Infant wide-field retinal image:
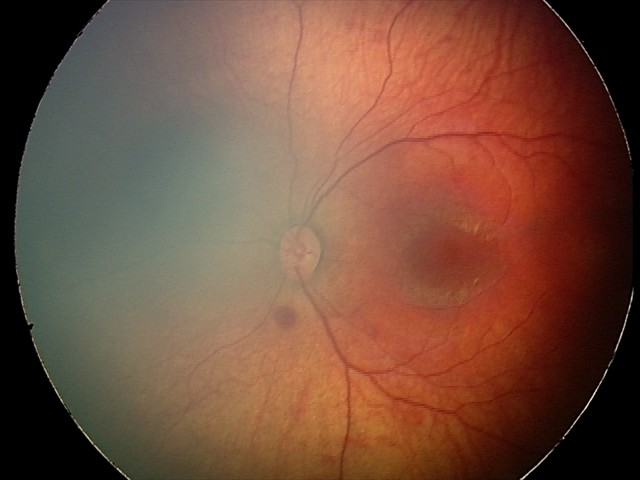

Screening examination consistent with retinal hemorrhages.